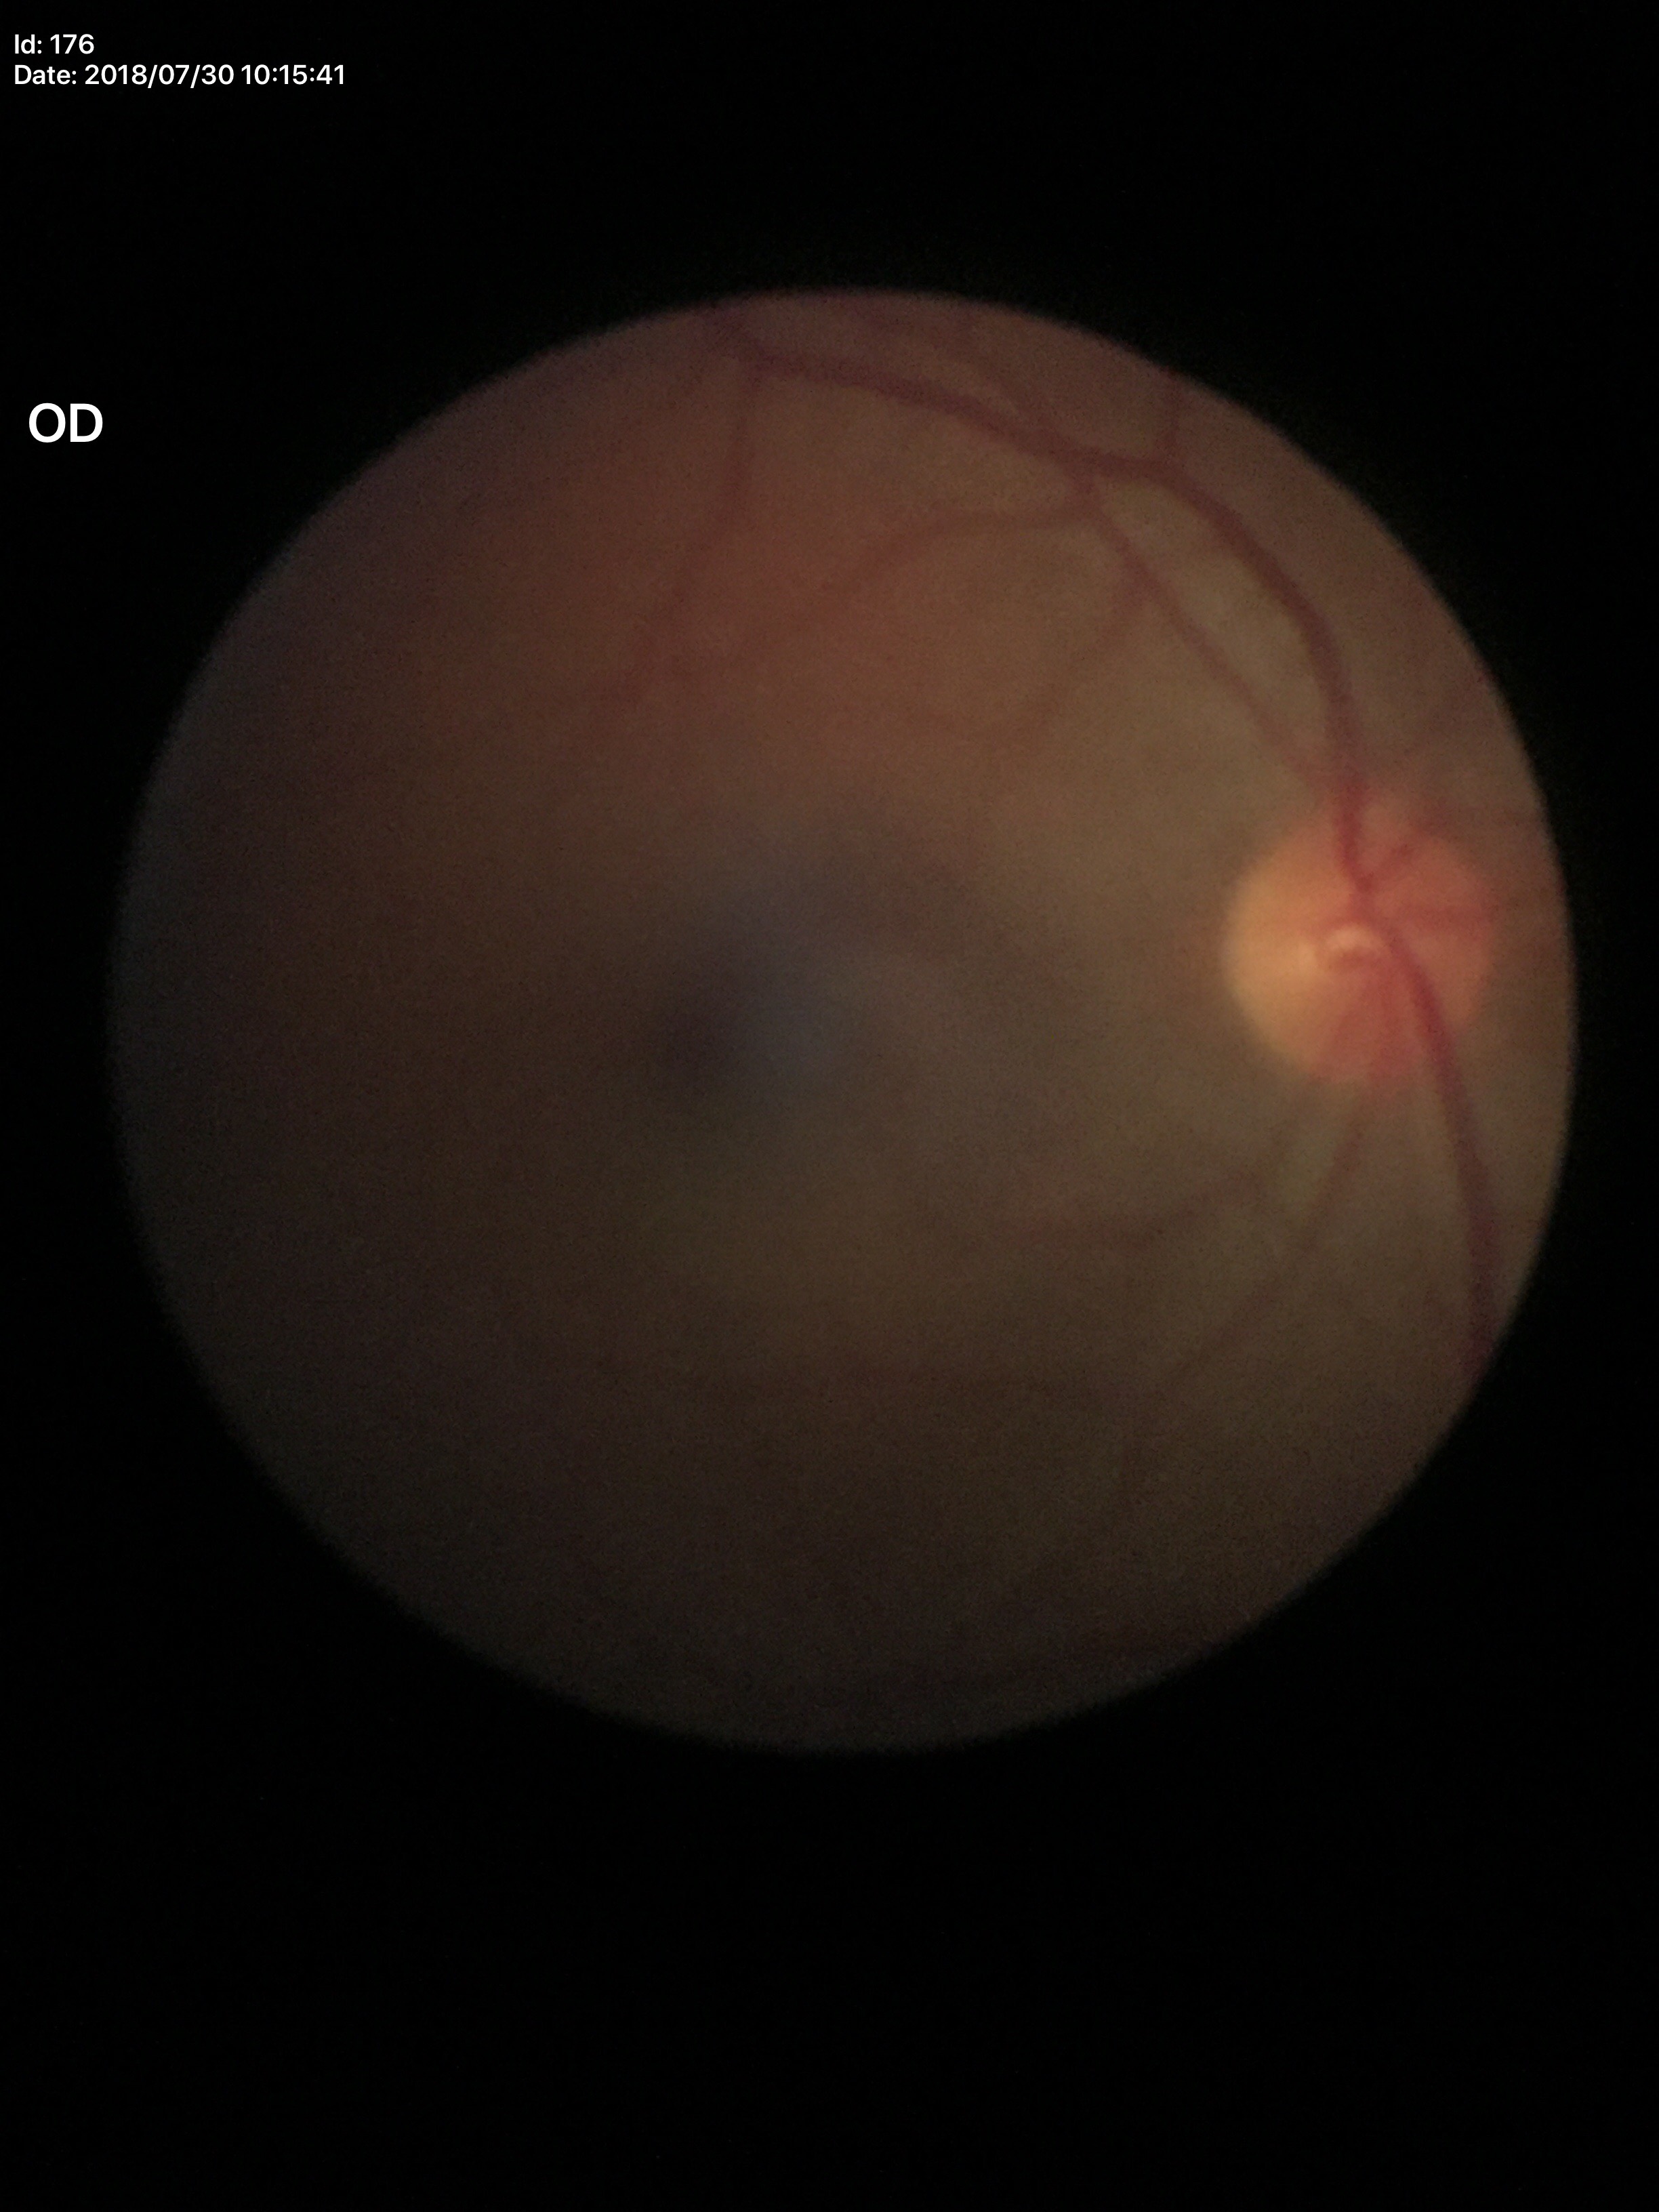 Glaucoma assessment: negative (5/5 ophthalmologists in agreement). VCDR: 0.40.